Color fundus photograph: 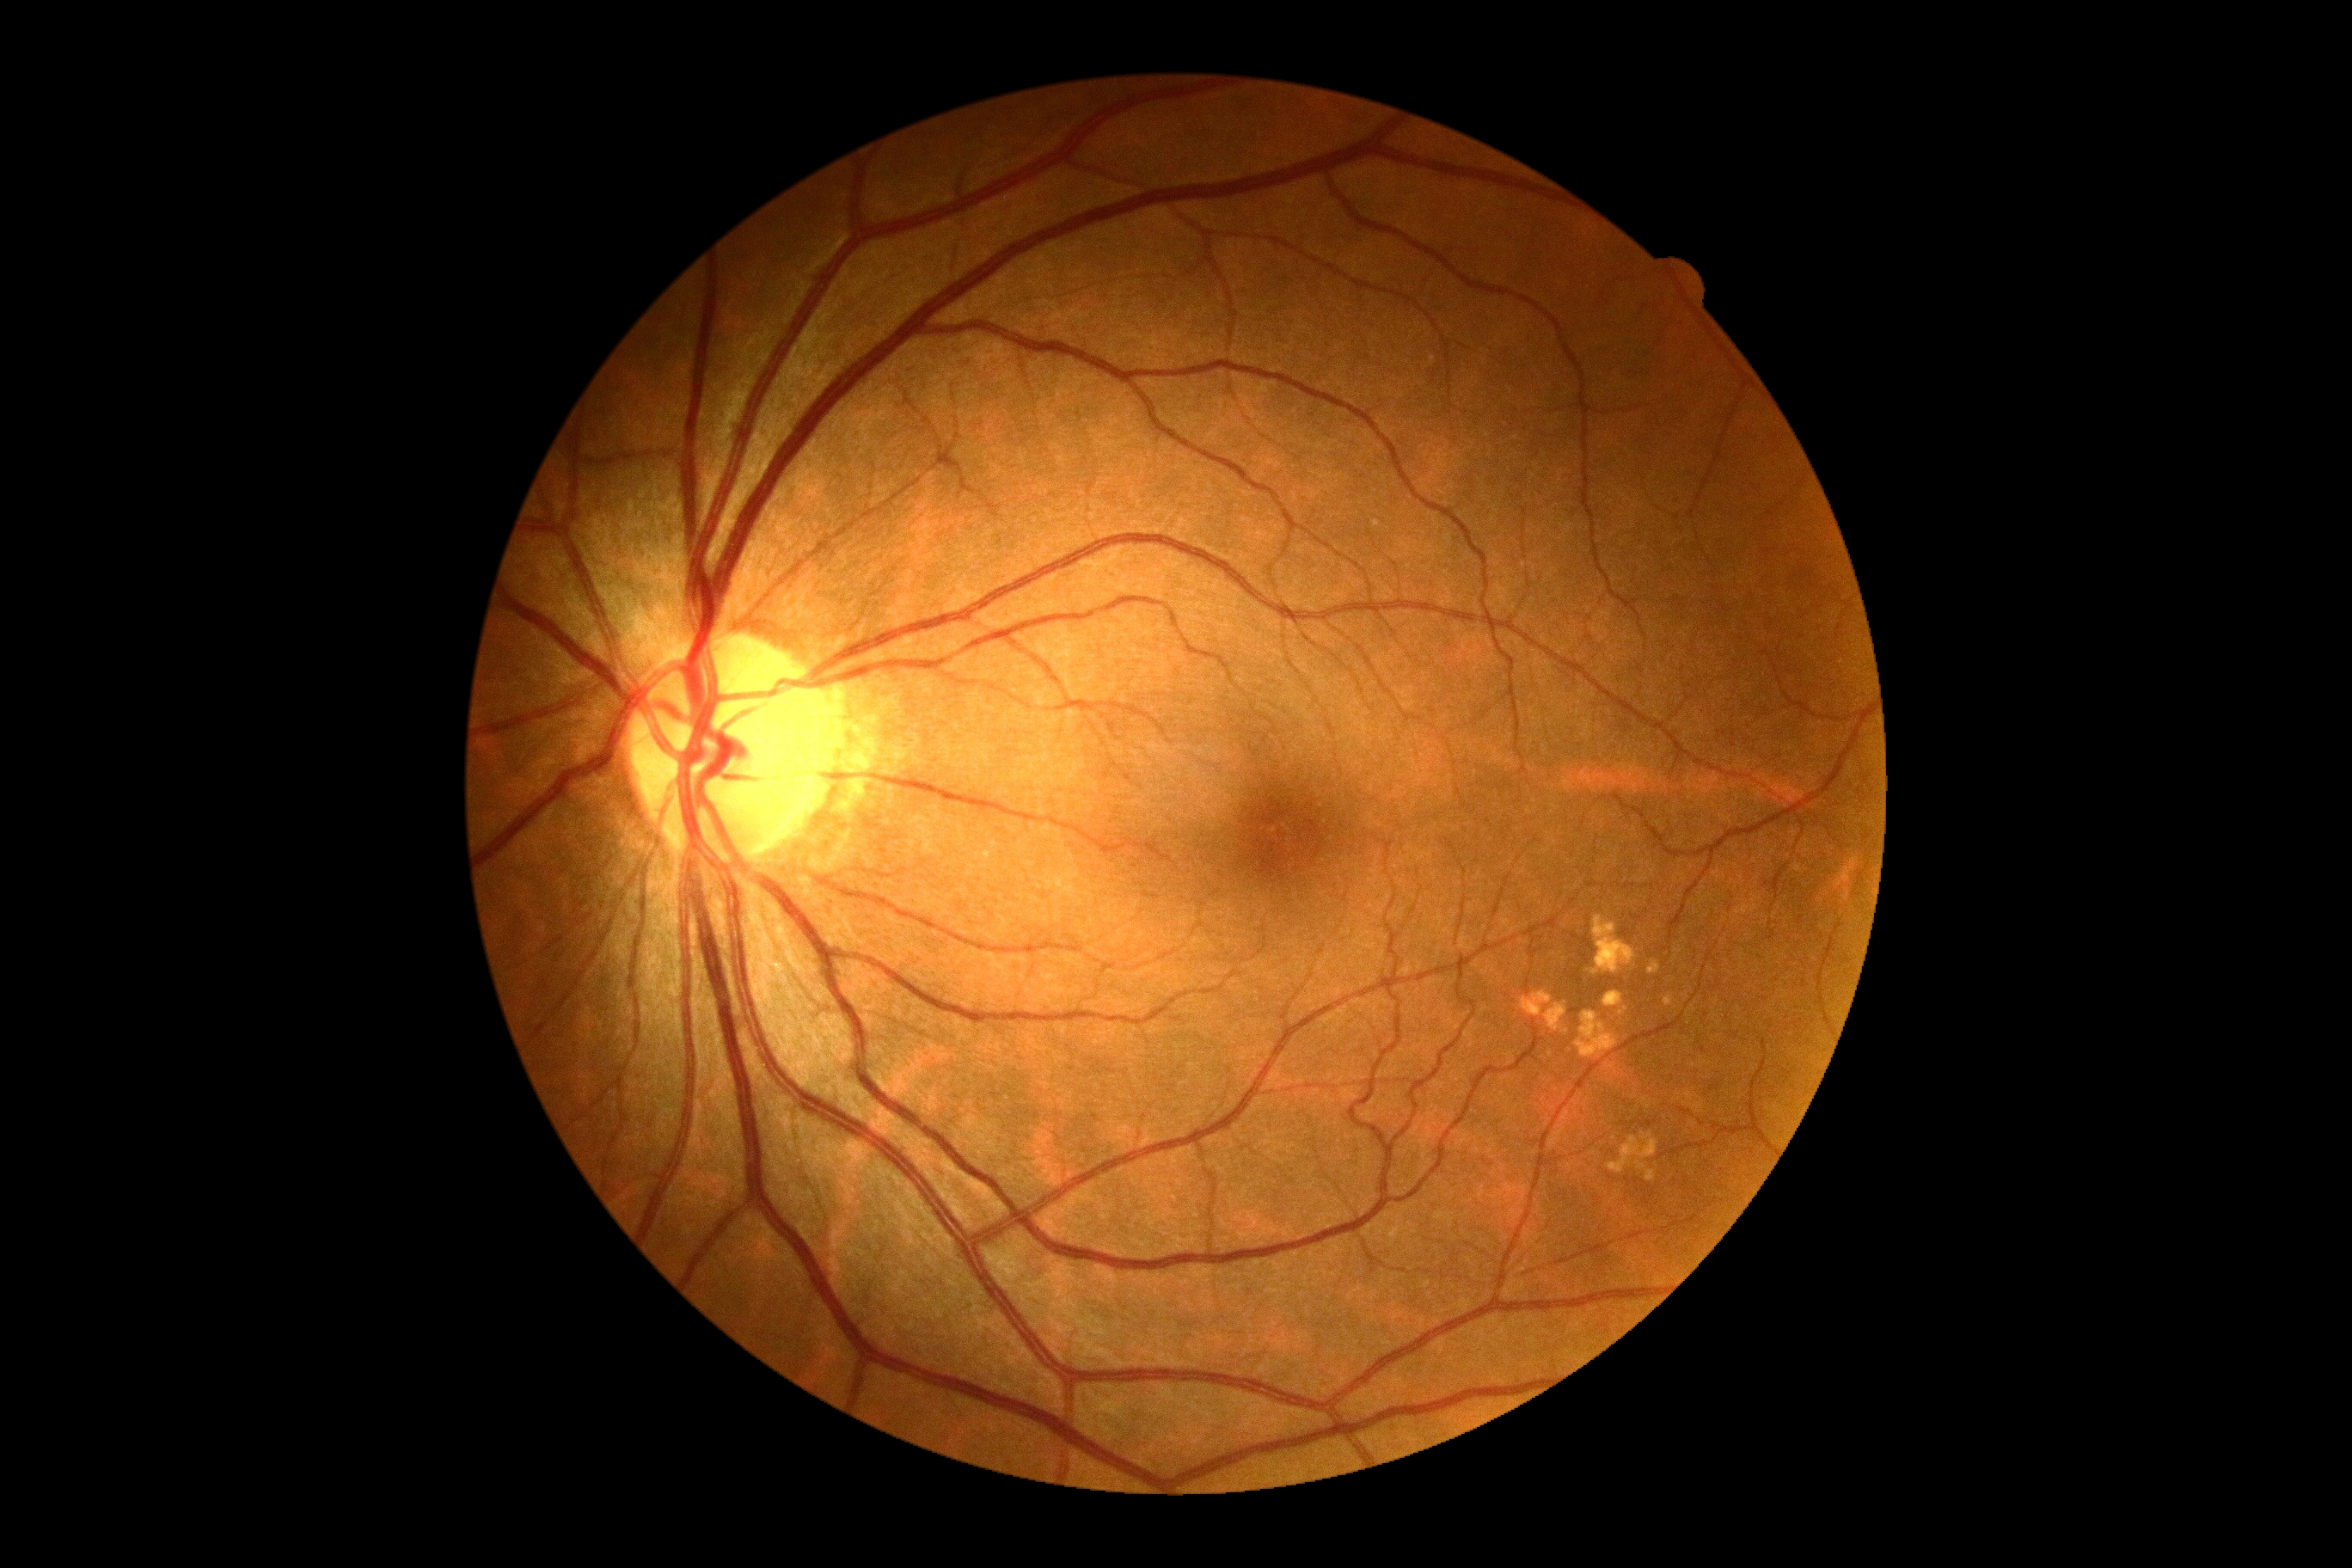
Retinopathy is grade 0 (no apparent retinopathy).